45° field of view.
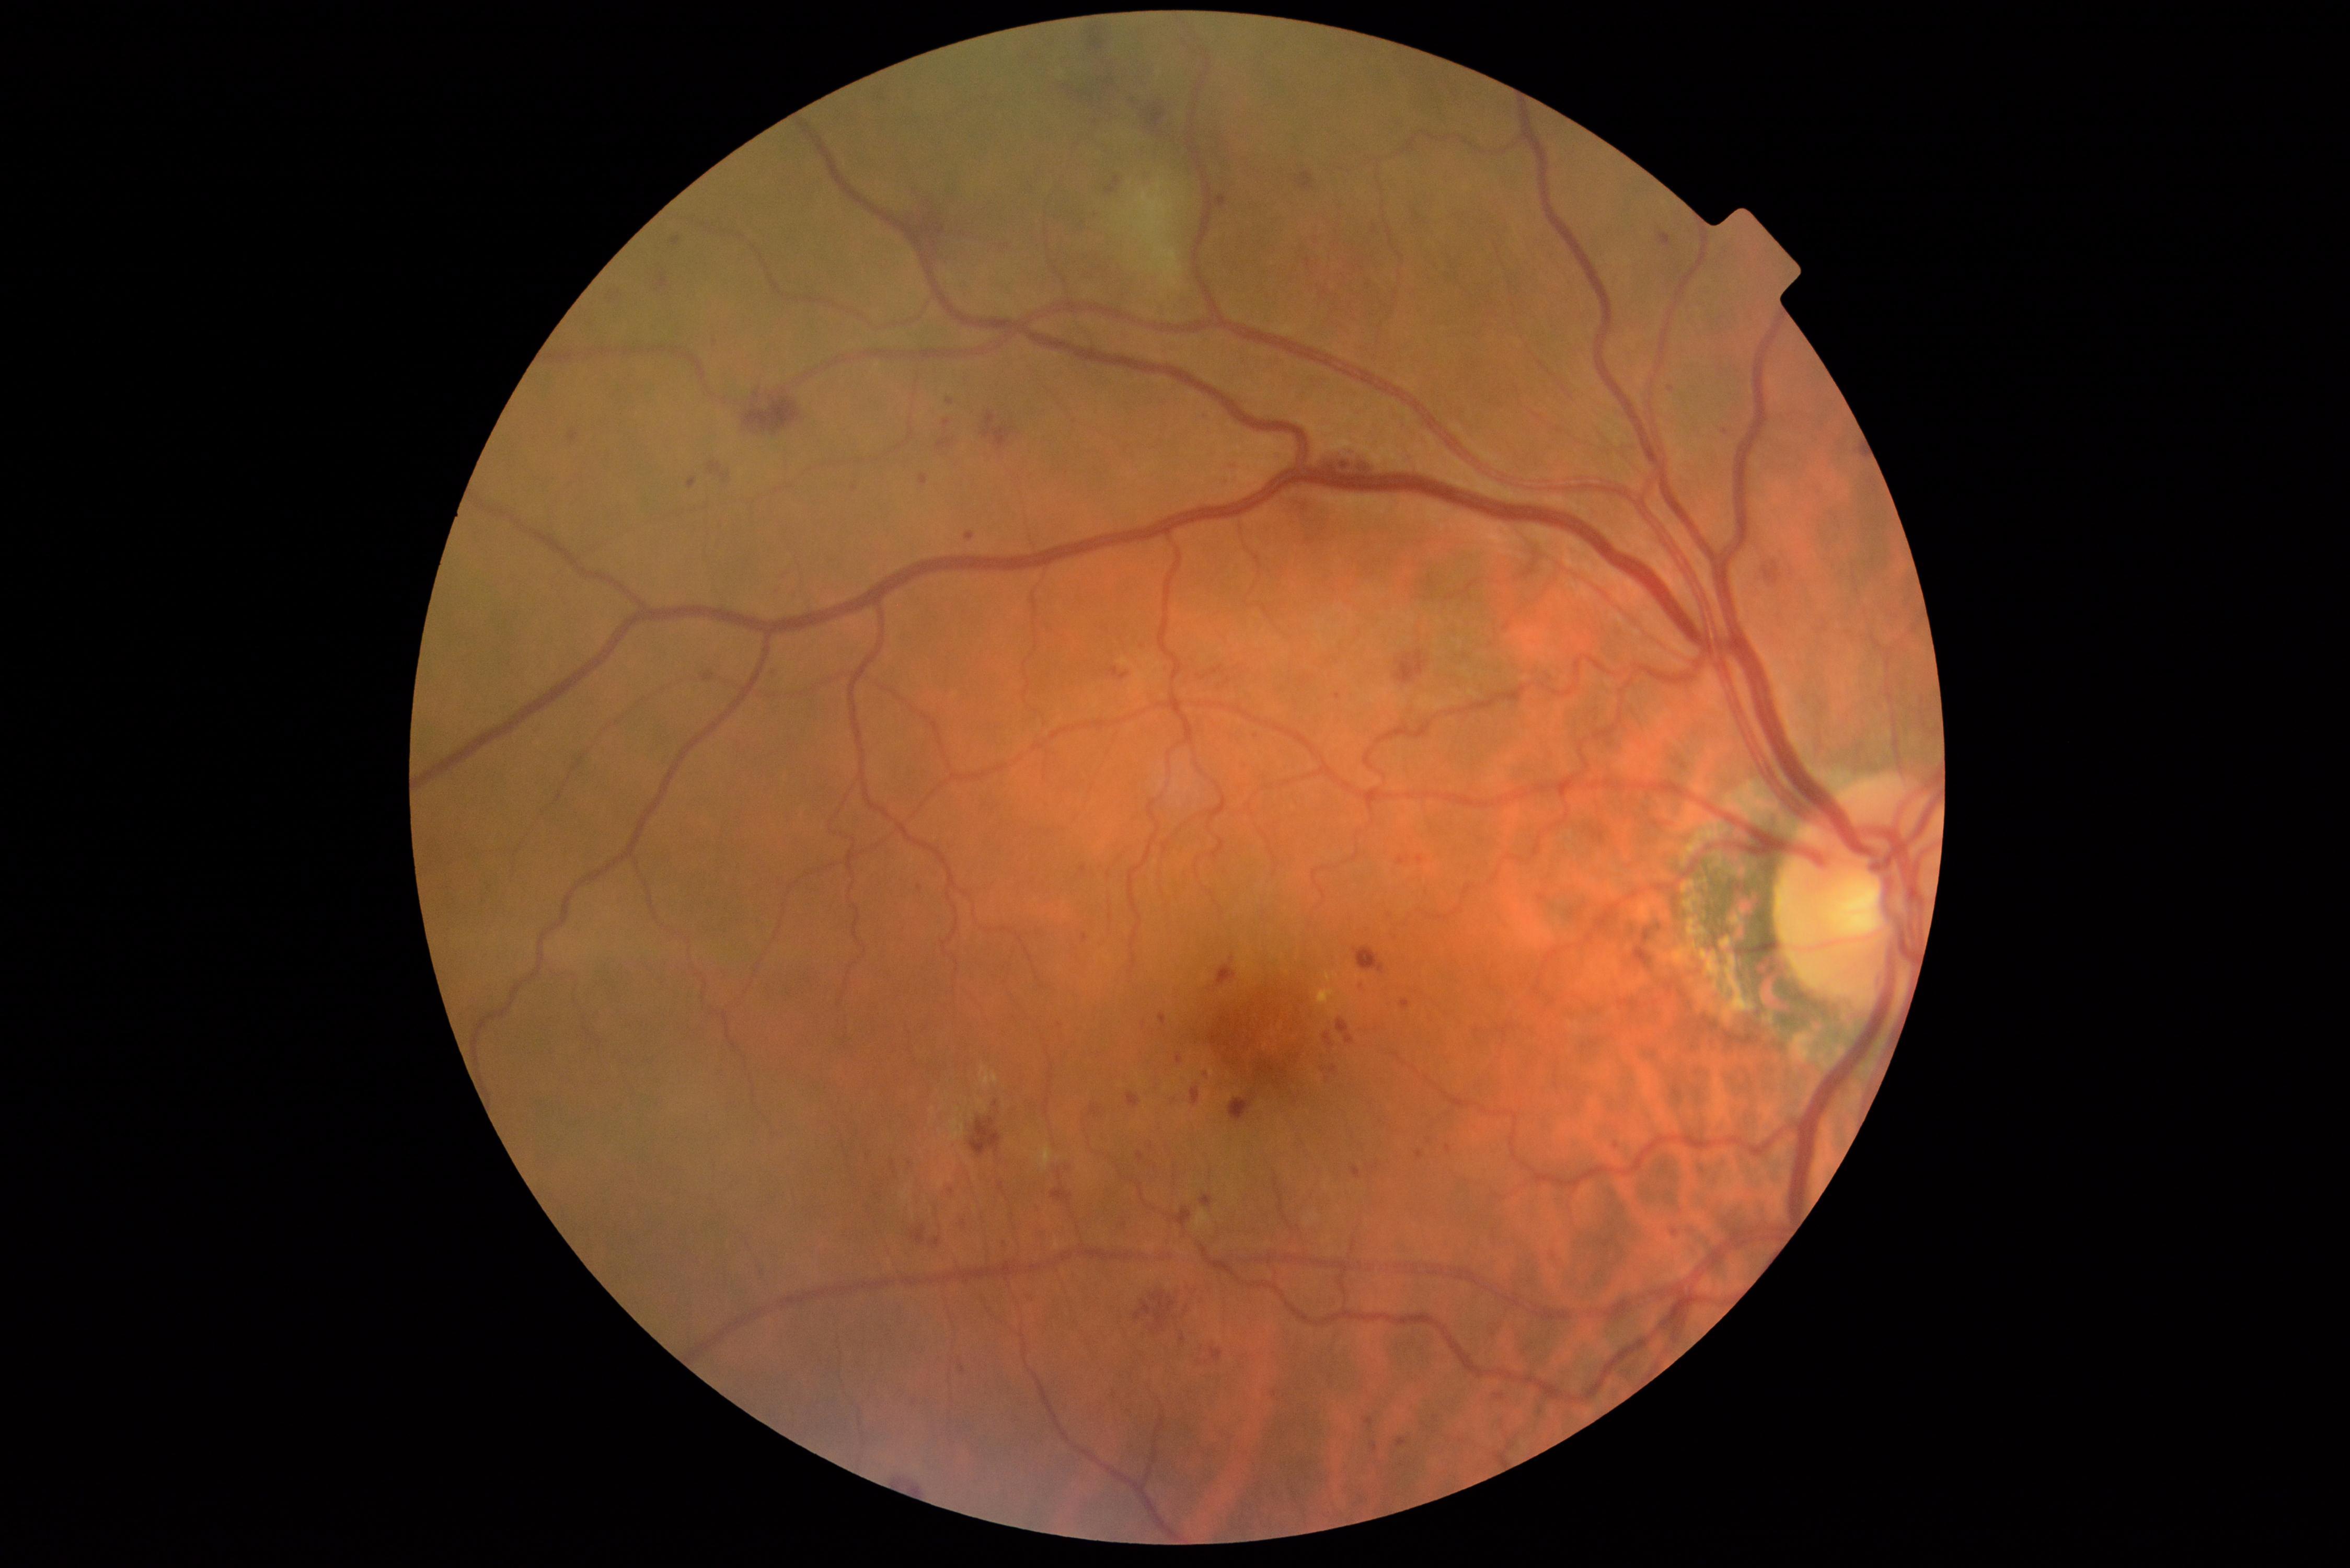
DR is 3.